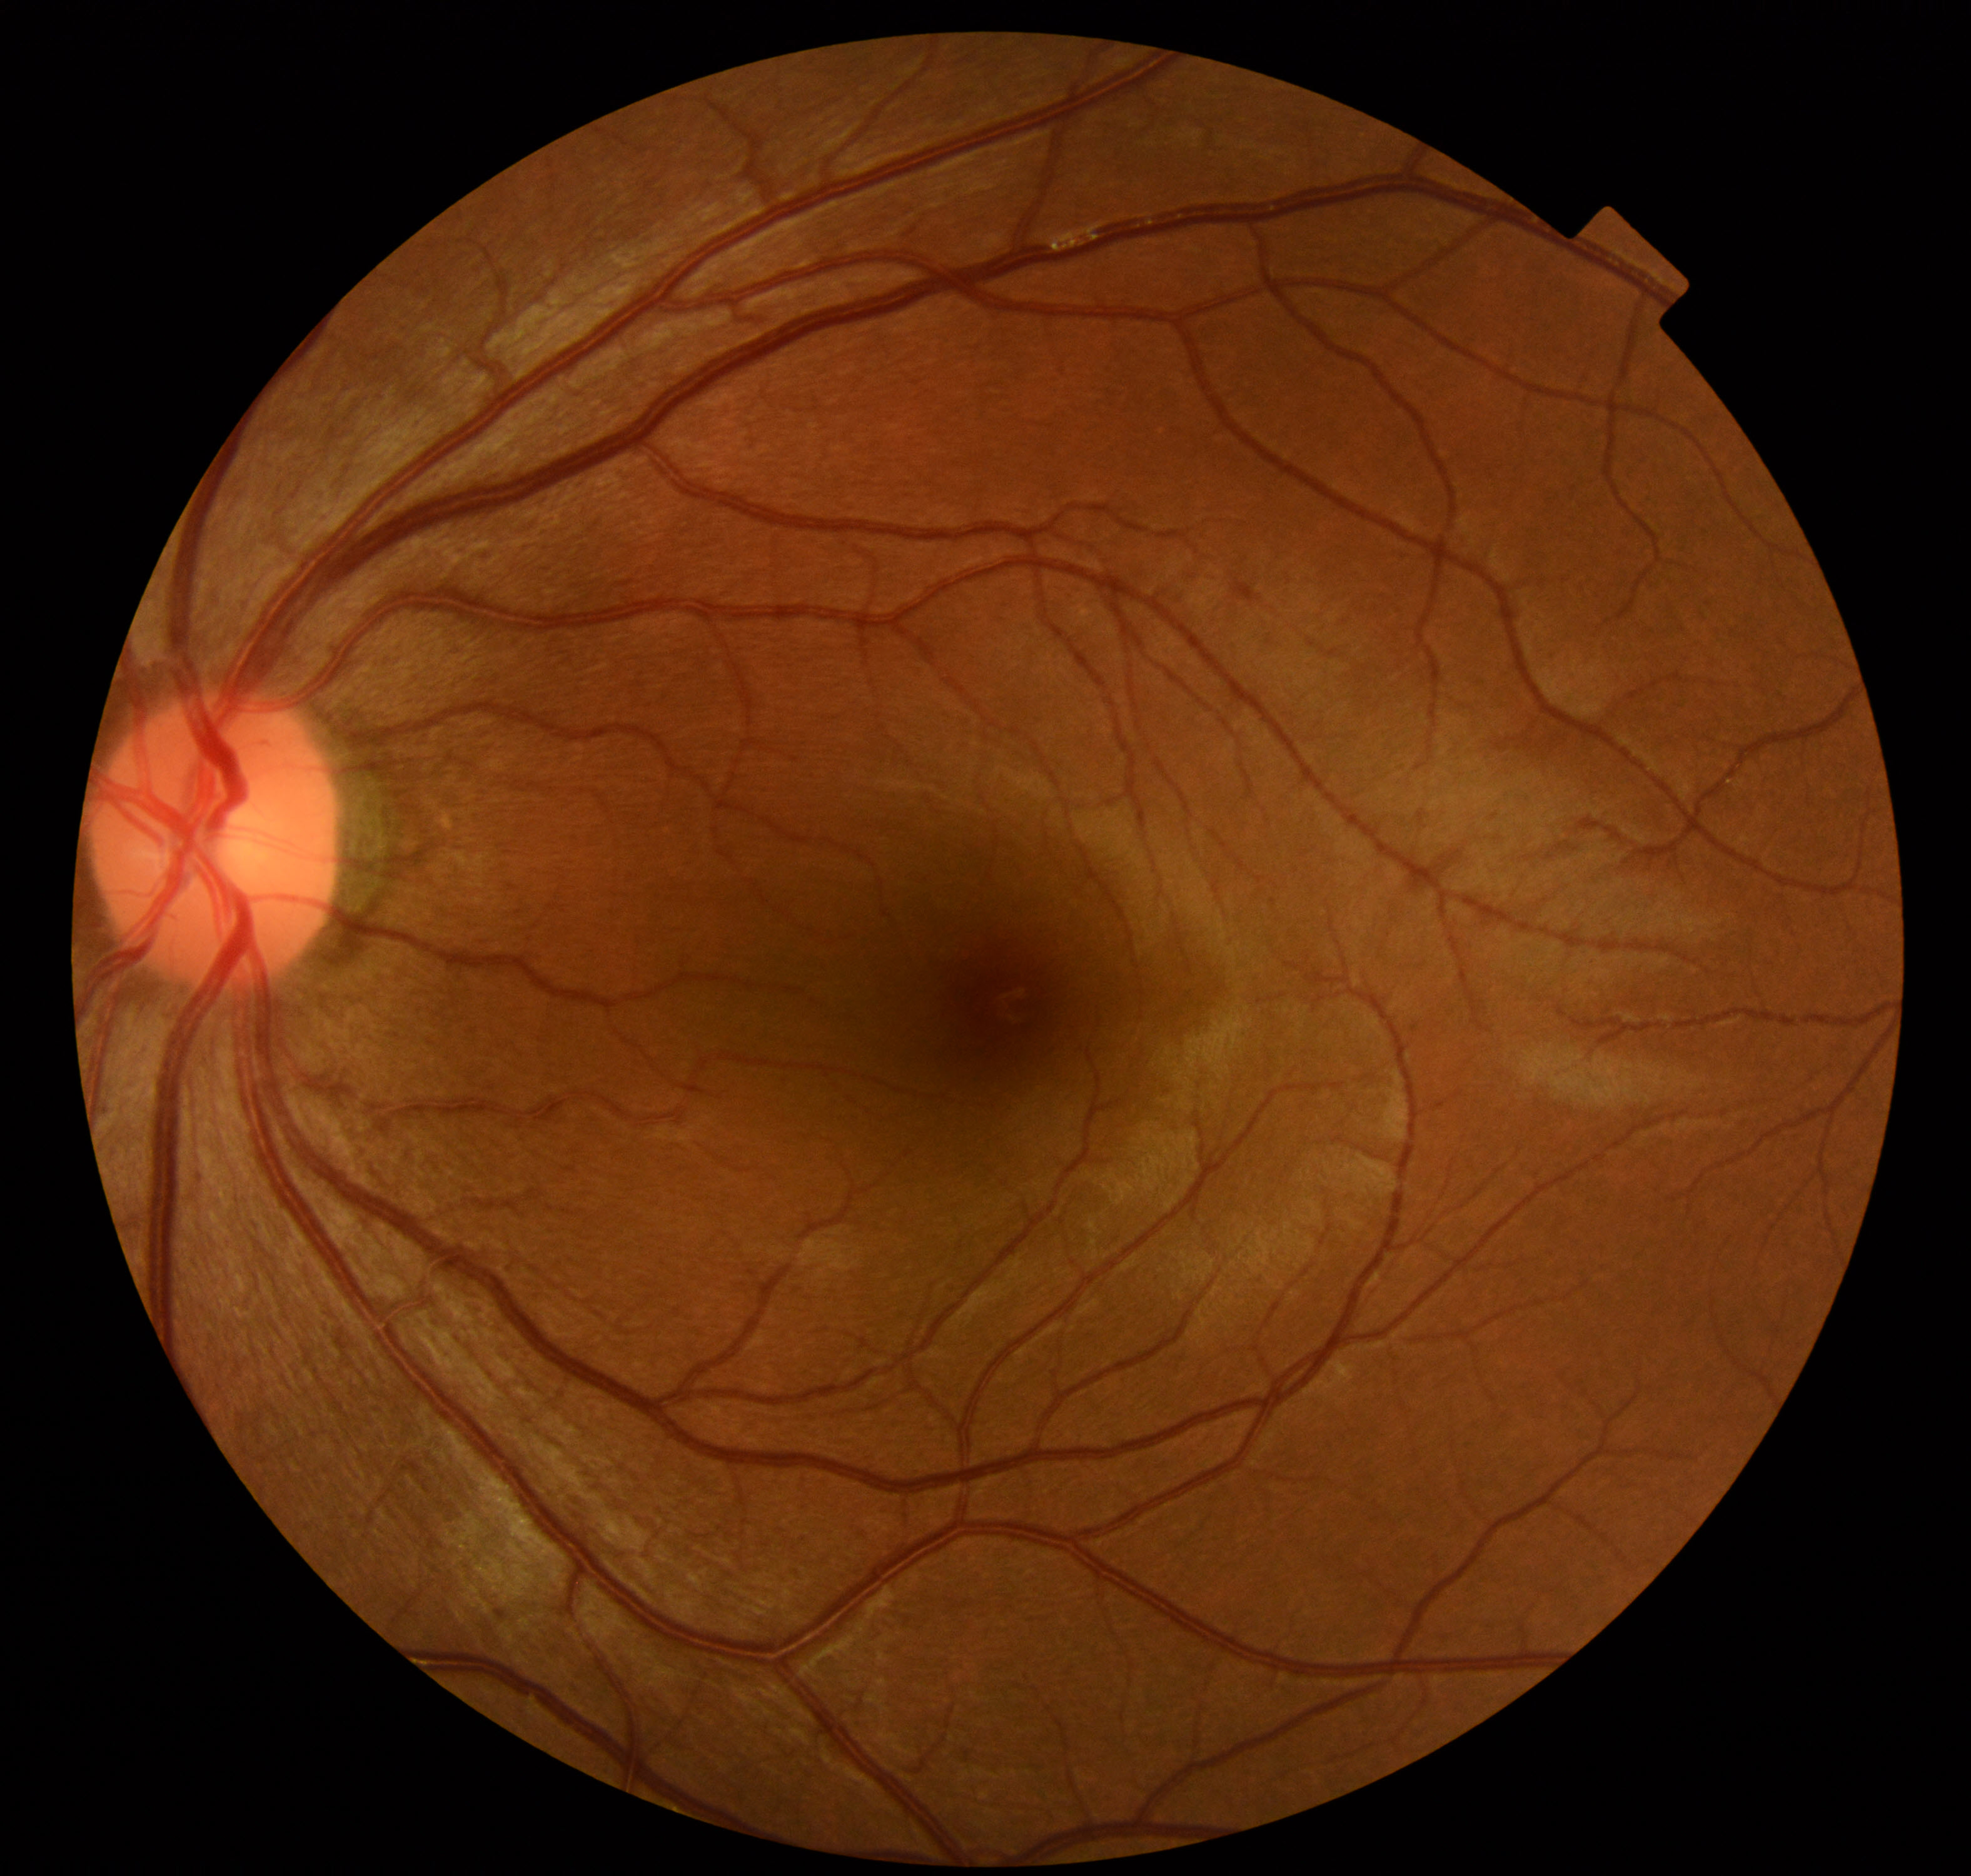
Findings: no abnormalities.